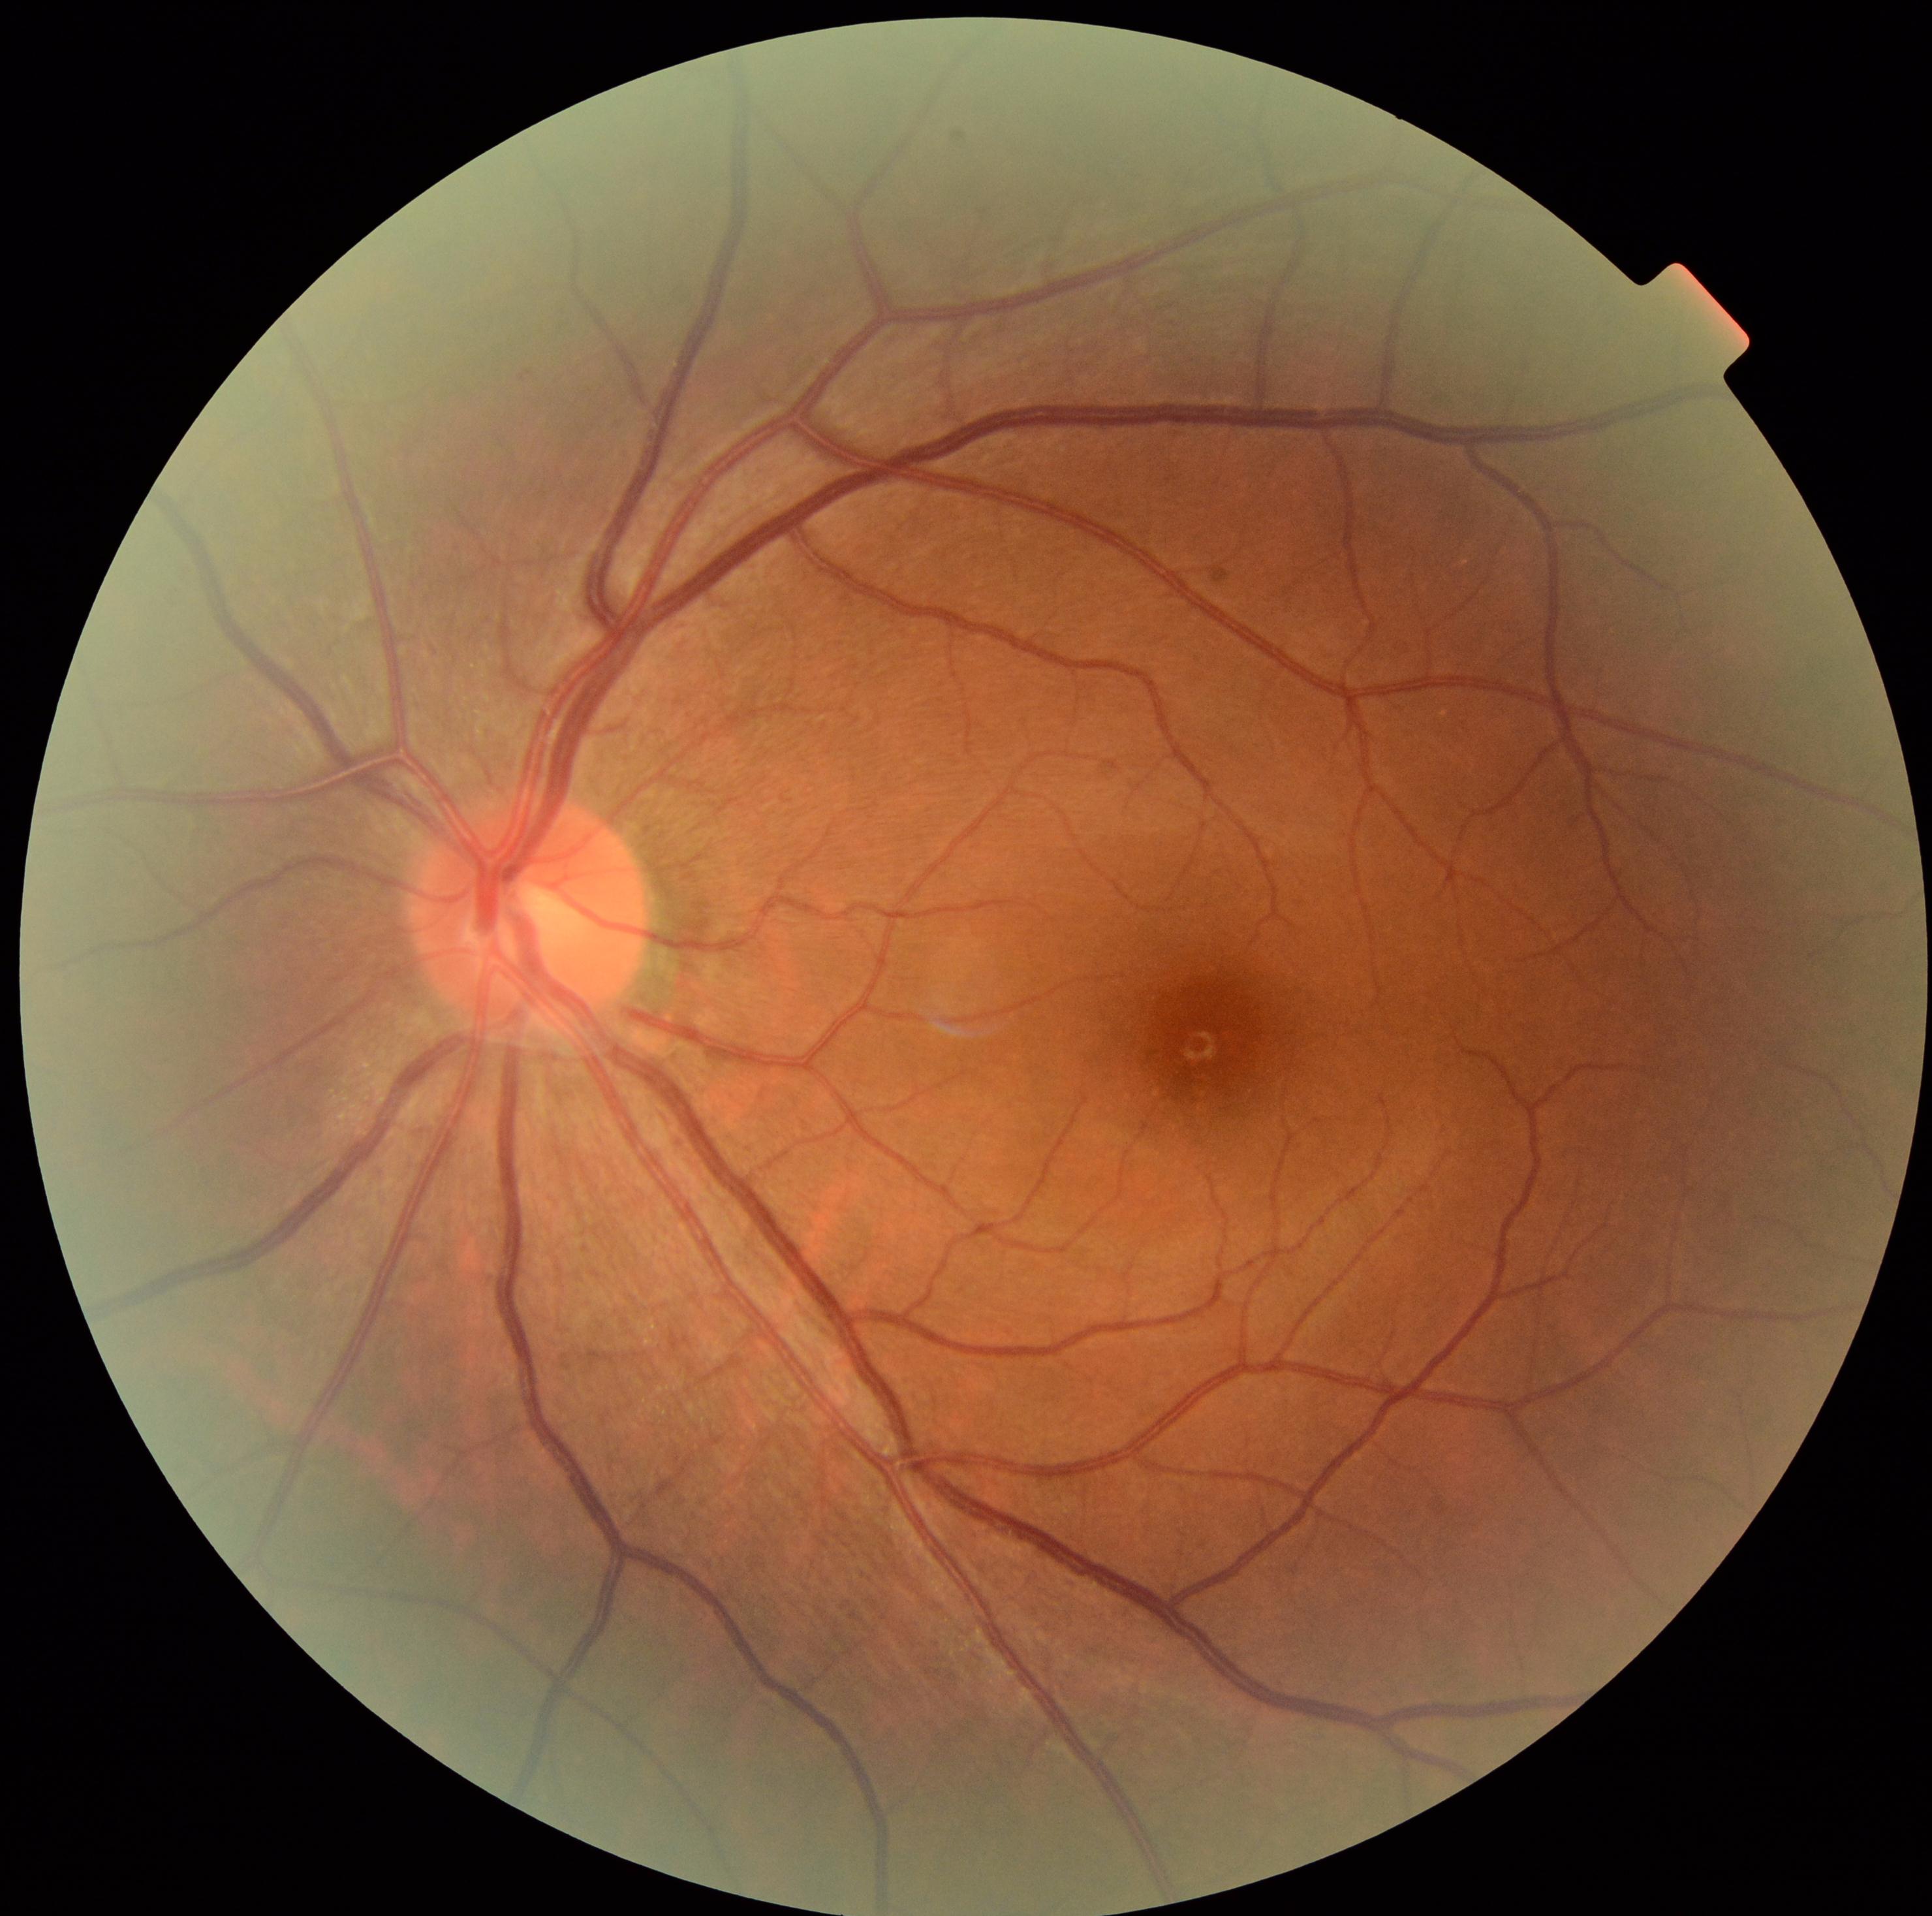

diabetic retinopathy severity = no apparent retinopathy (grade 0).